Wide-field fundus photograph from neonatal ROP screening · captured with the Phoenix ICON (100° field of view): 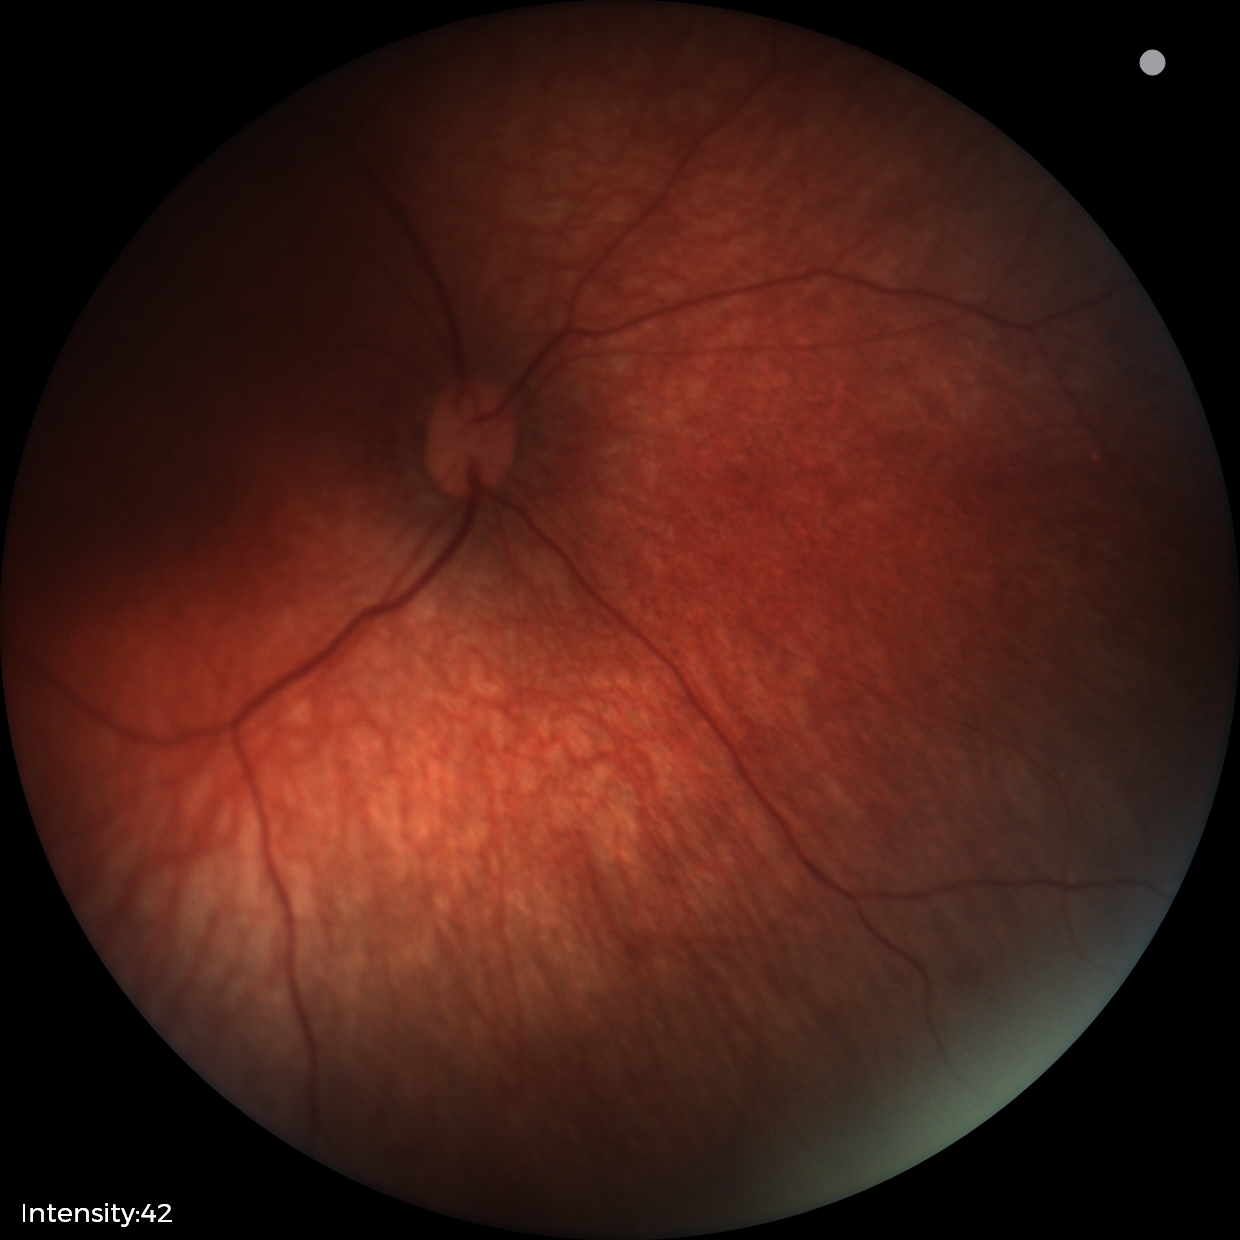 Examination with physiological retinal findings.